Fundus photo · 848x848px · nonmydriatic fundus photograph · modified Davis classification · FOV: 45 degrees.
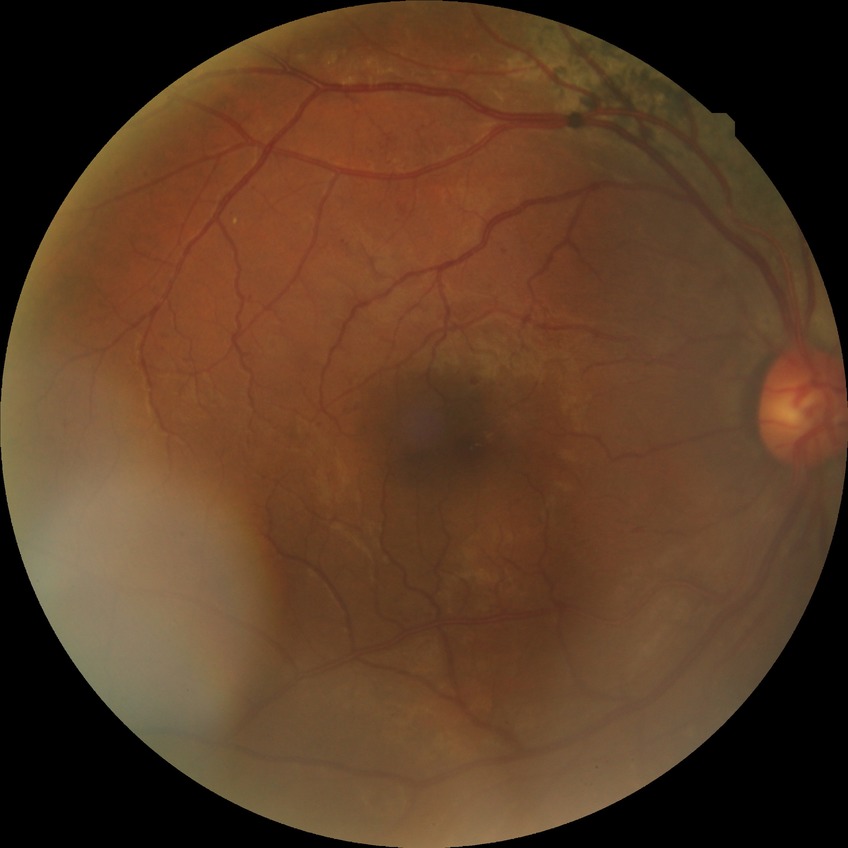 Modified Davis grading is pre-proliferative diabetic retinopathy.